Fundus photo · 848 x 848 pixels.
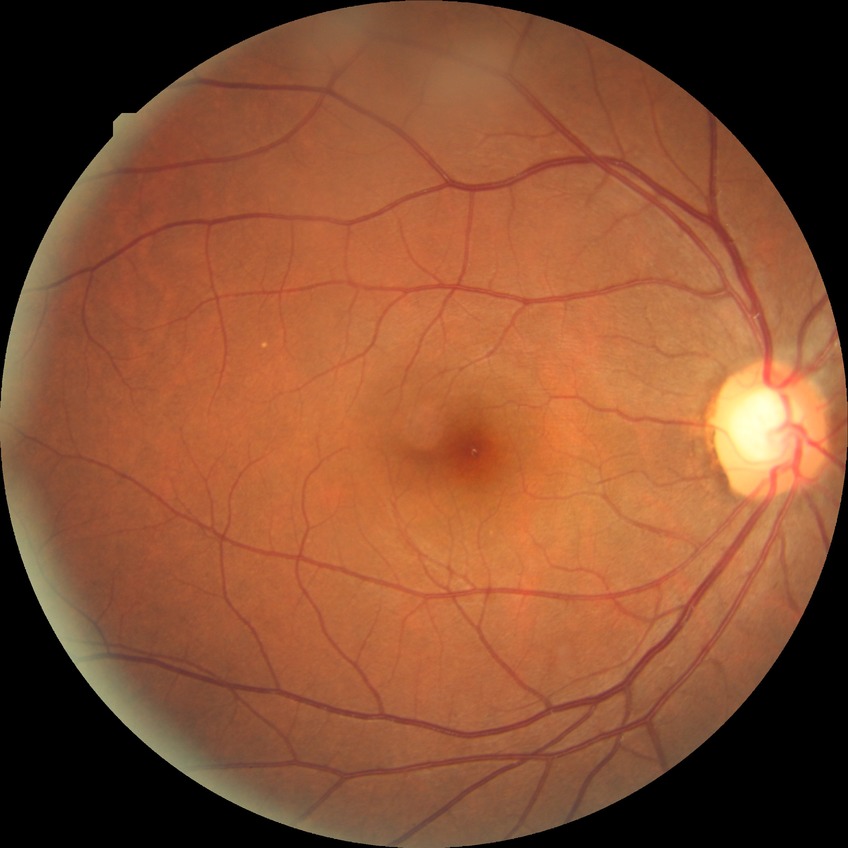 davis_grade: no diabetic retinopathy (NDR)